Nonmydriatic fundus photograph, NIDEK AFC-230 fundus camera, 848x848, 45-degree field of view: 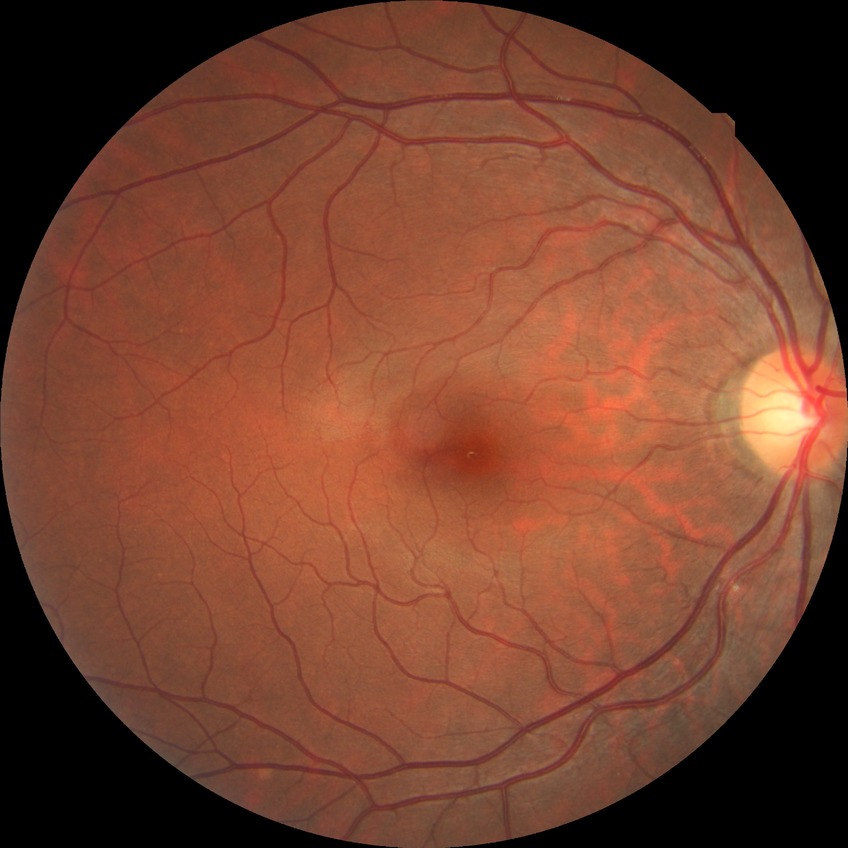
Diabetic retinopathy (DR): no diabetic retinopathy (NDR).